FOV: 45 degrees. 2212x1659: 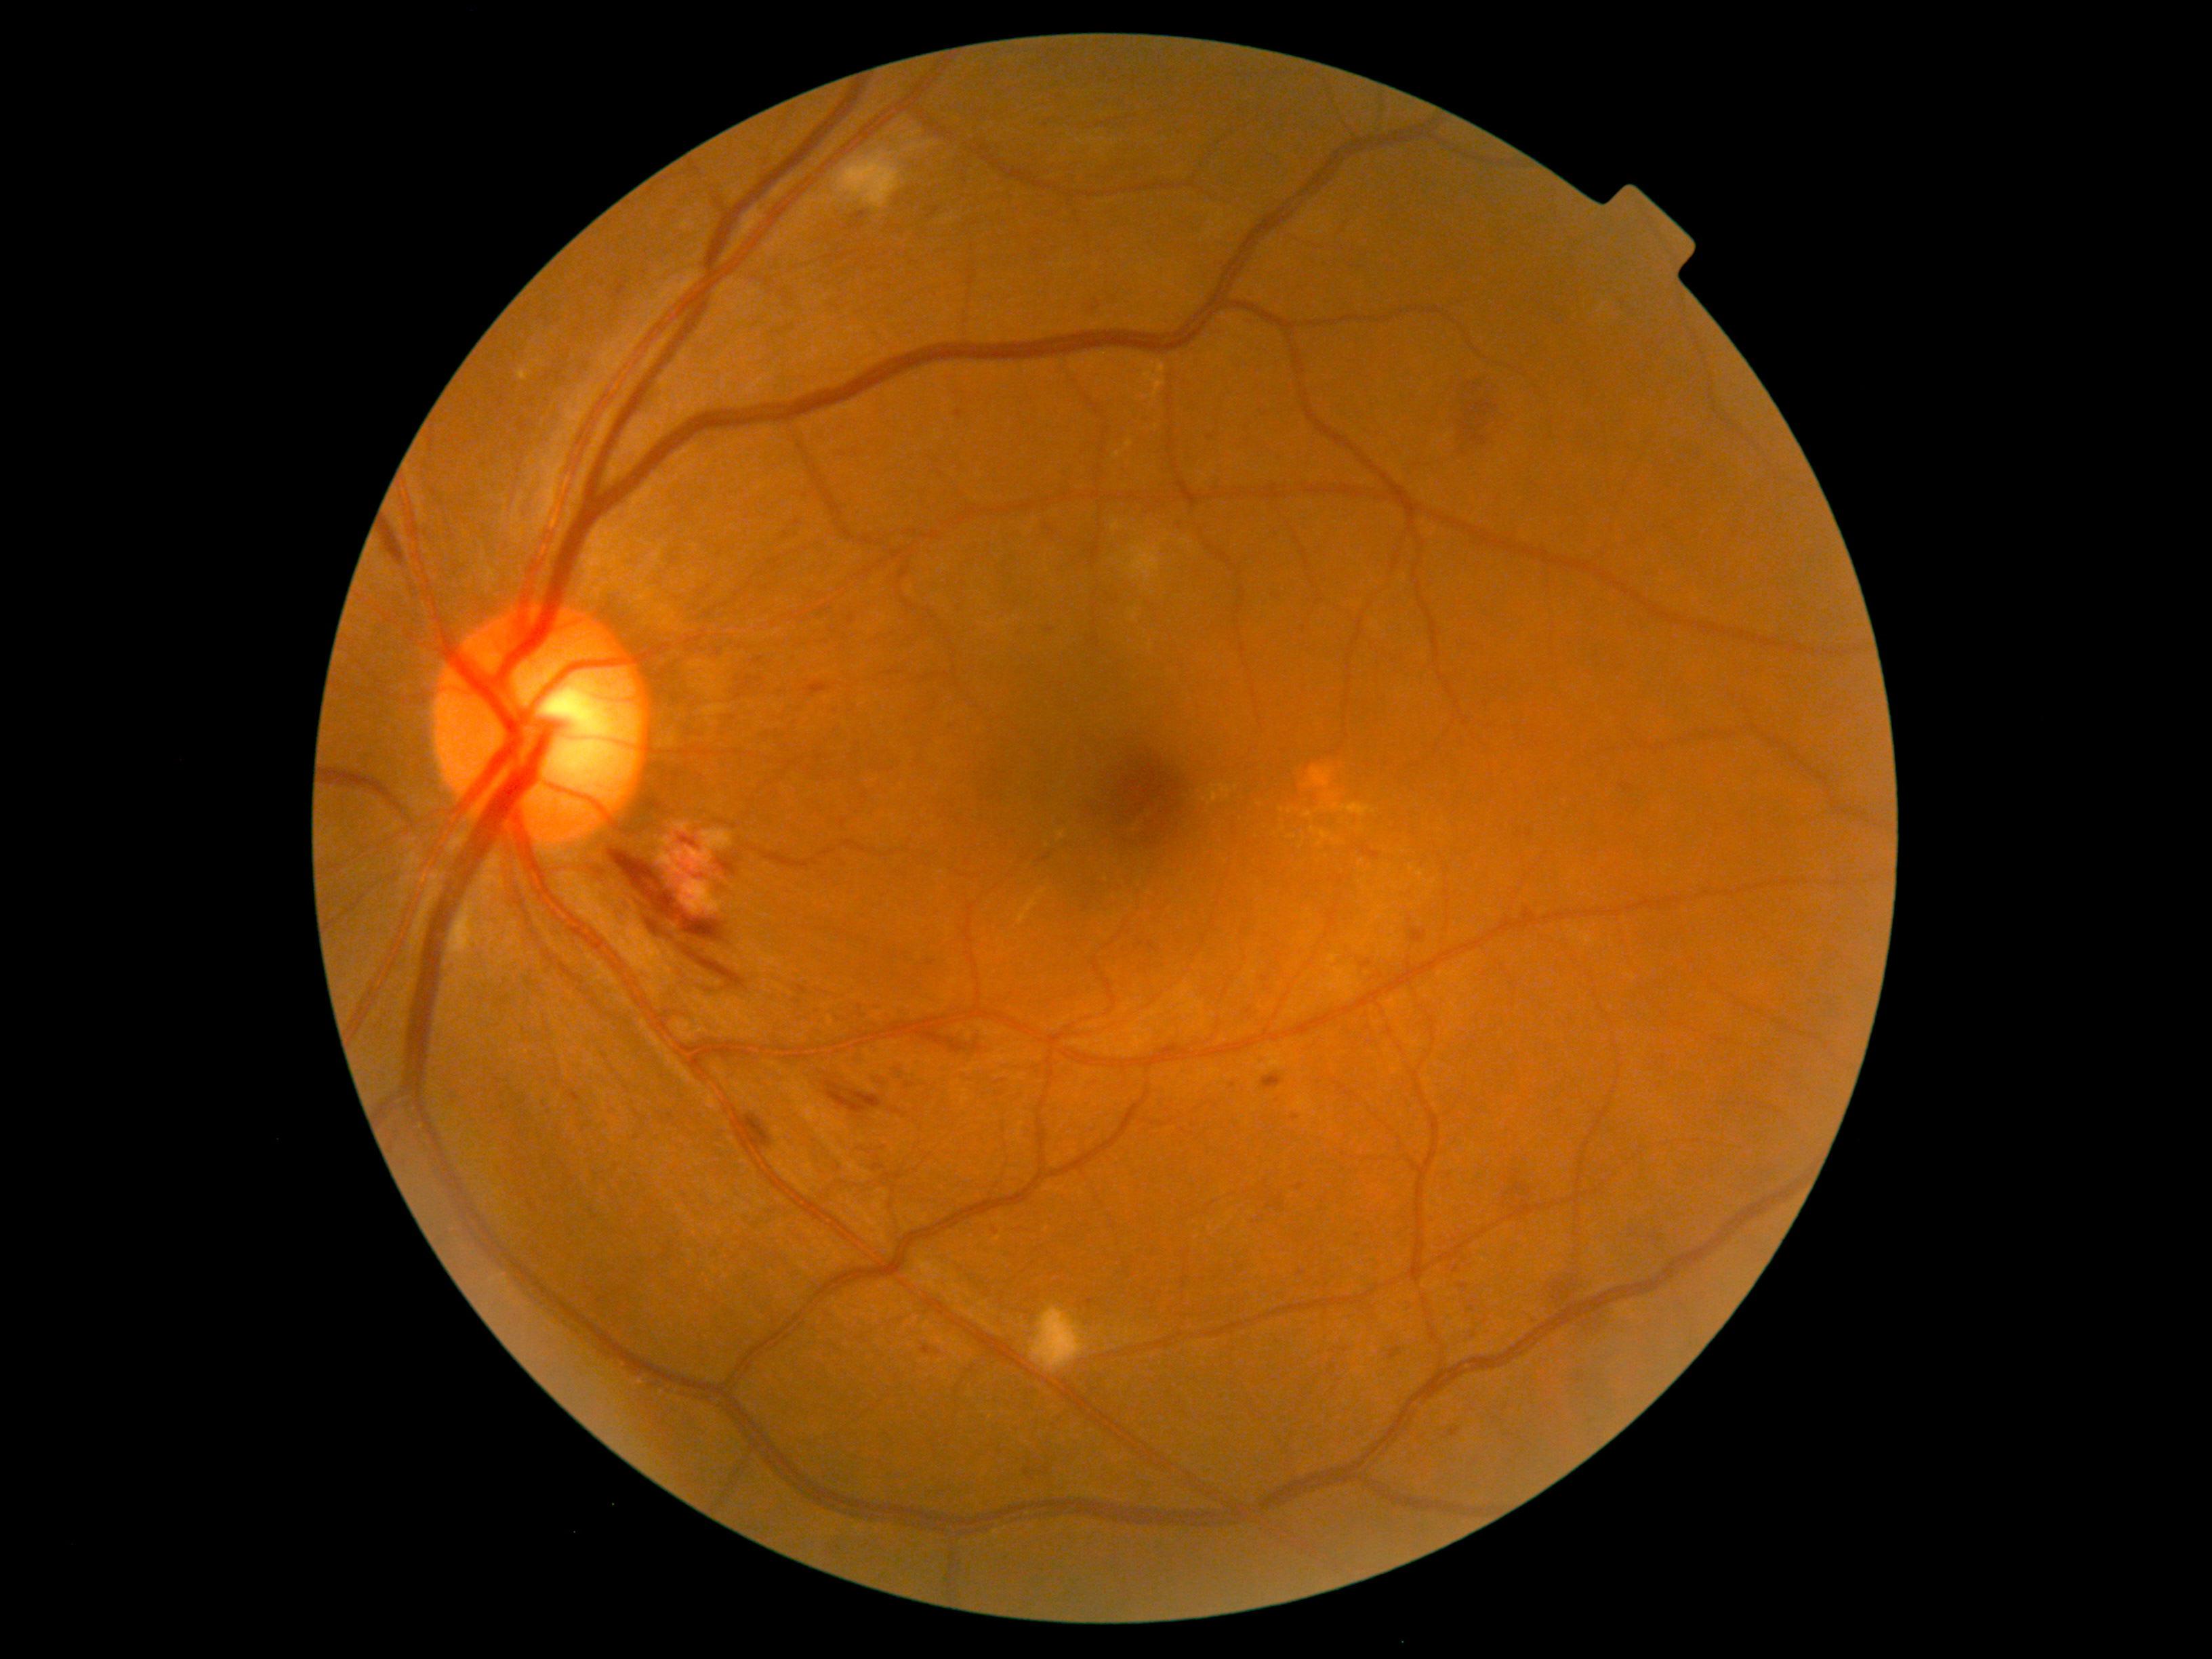

DR grade: 2 (moderate NPDR).